Color fundus image, FOV: 45 degrees:
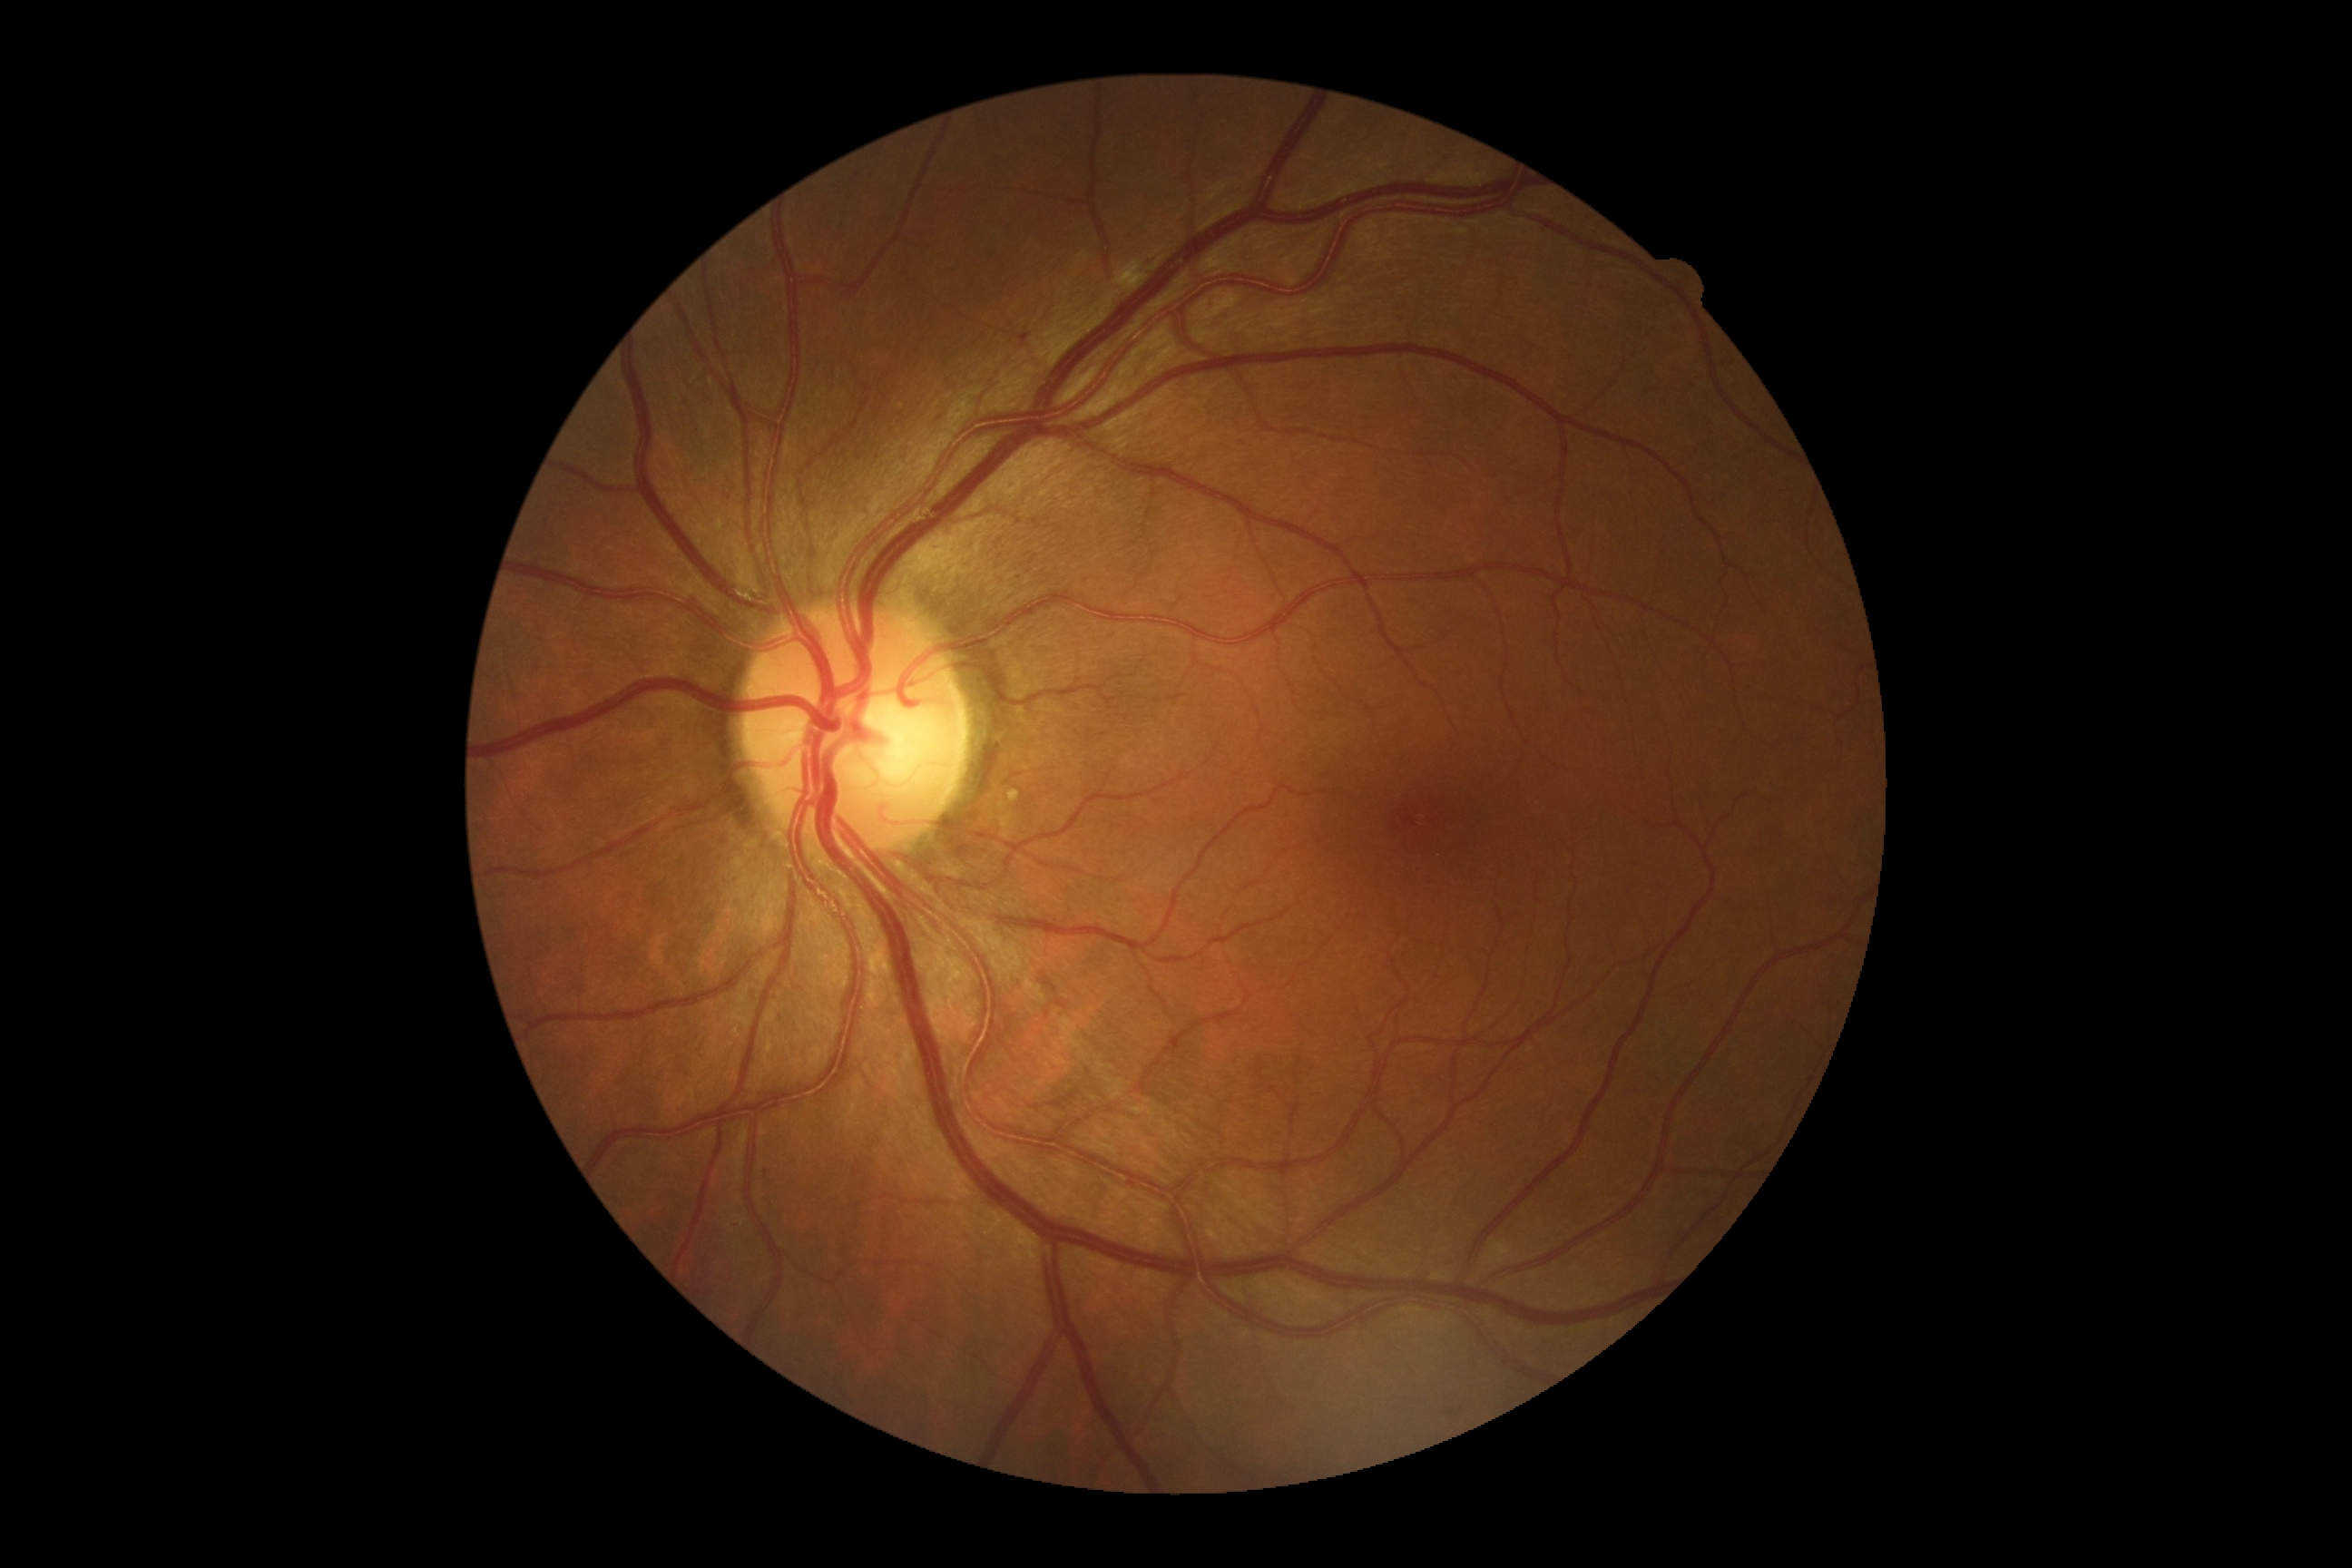

Findings:
* DR stage: 2